Woman · corneal thickness: 432 µm · image size 2212x1661 · axial length 25.42 mm · IOP 12 mmHg · patient age: 56 years
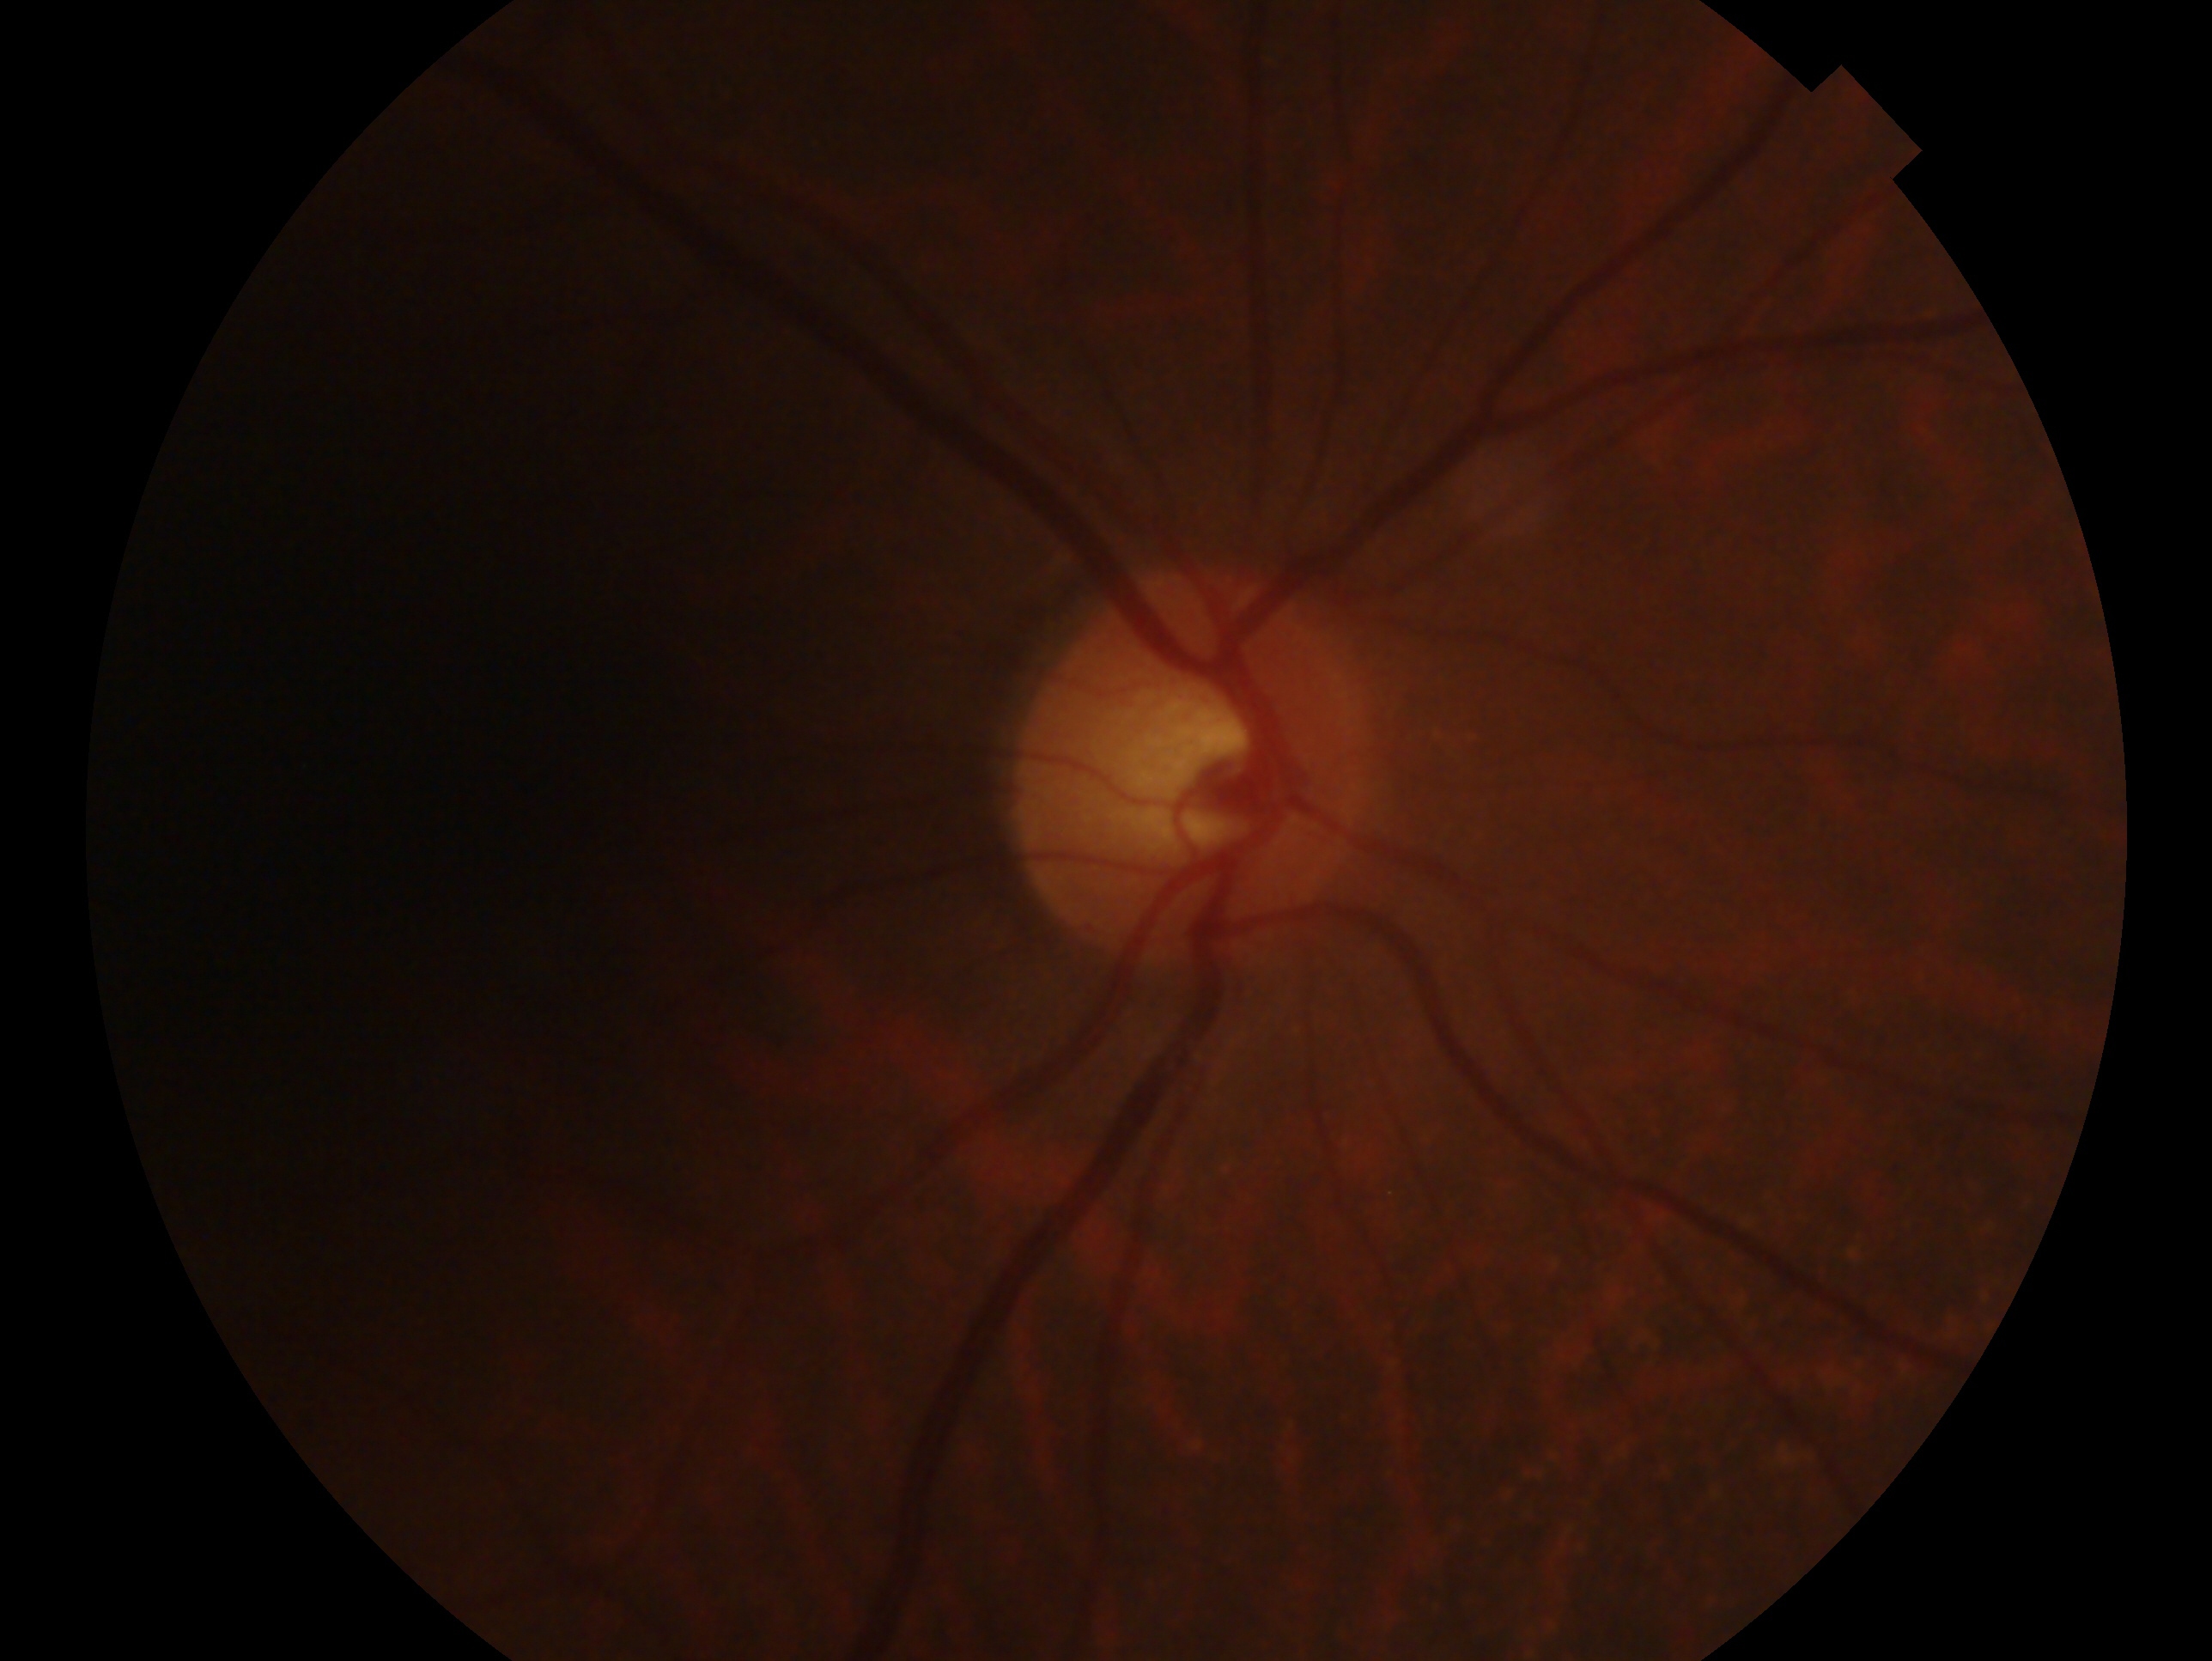
Imaged eye: right.
Assessment — no glaucoma.